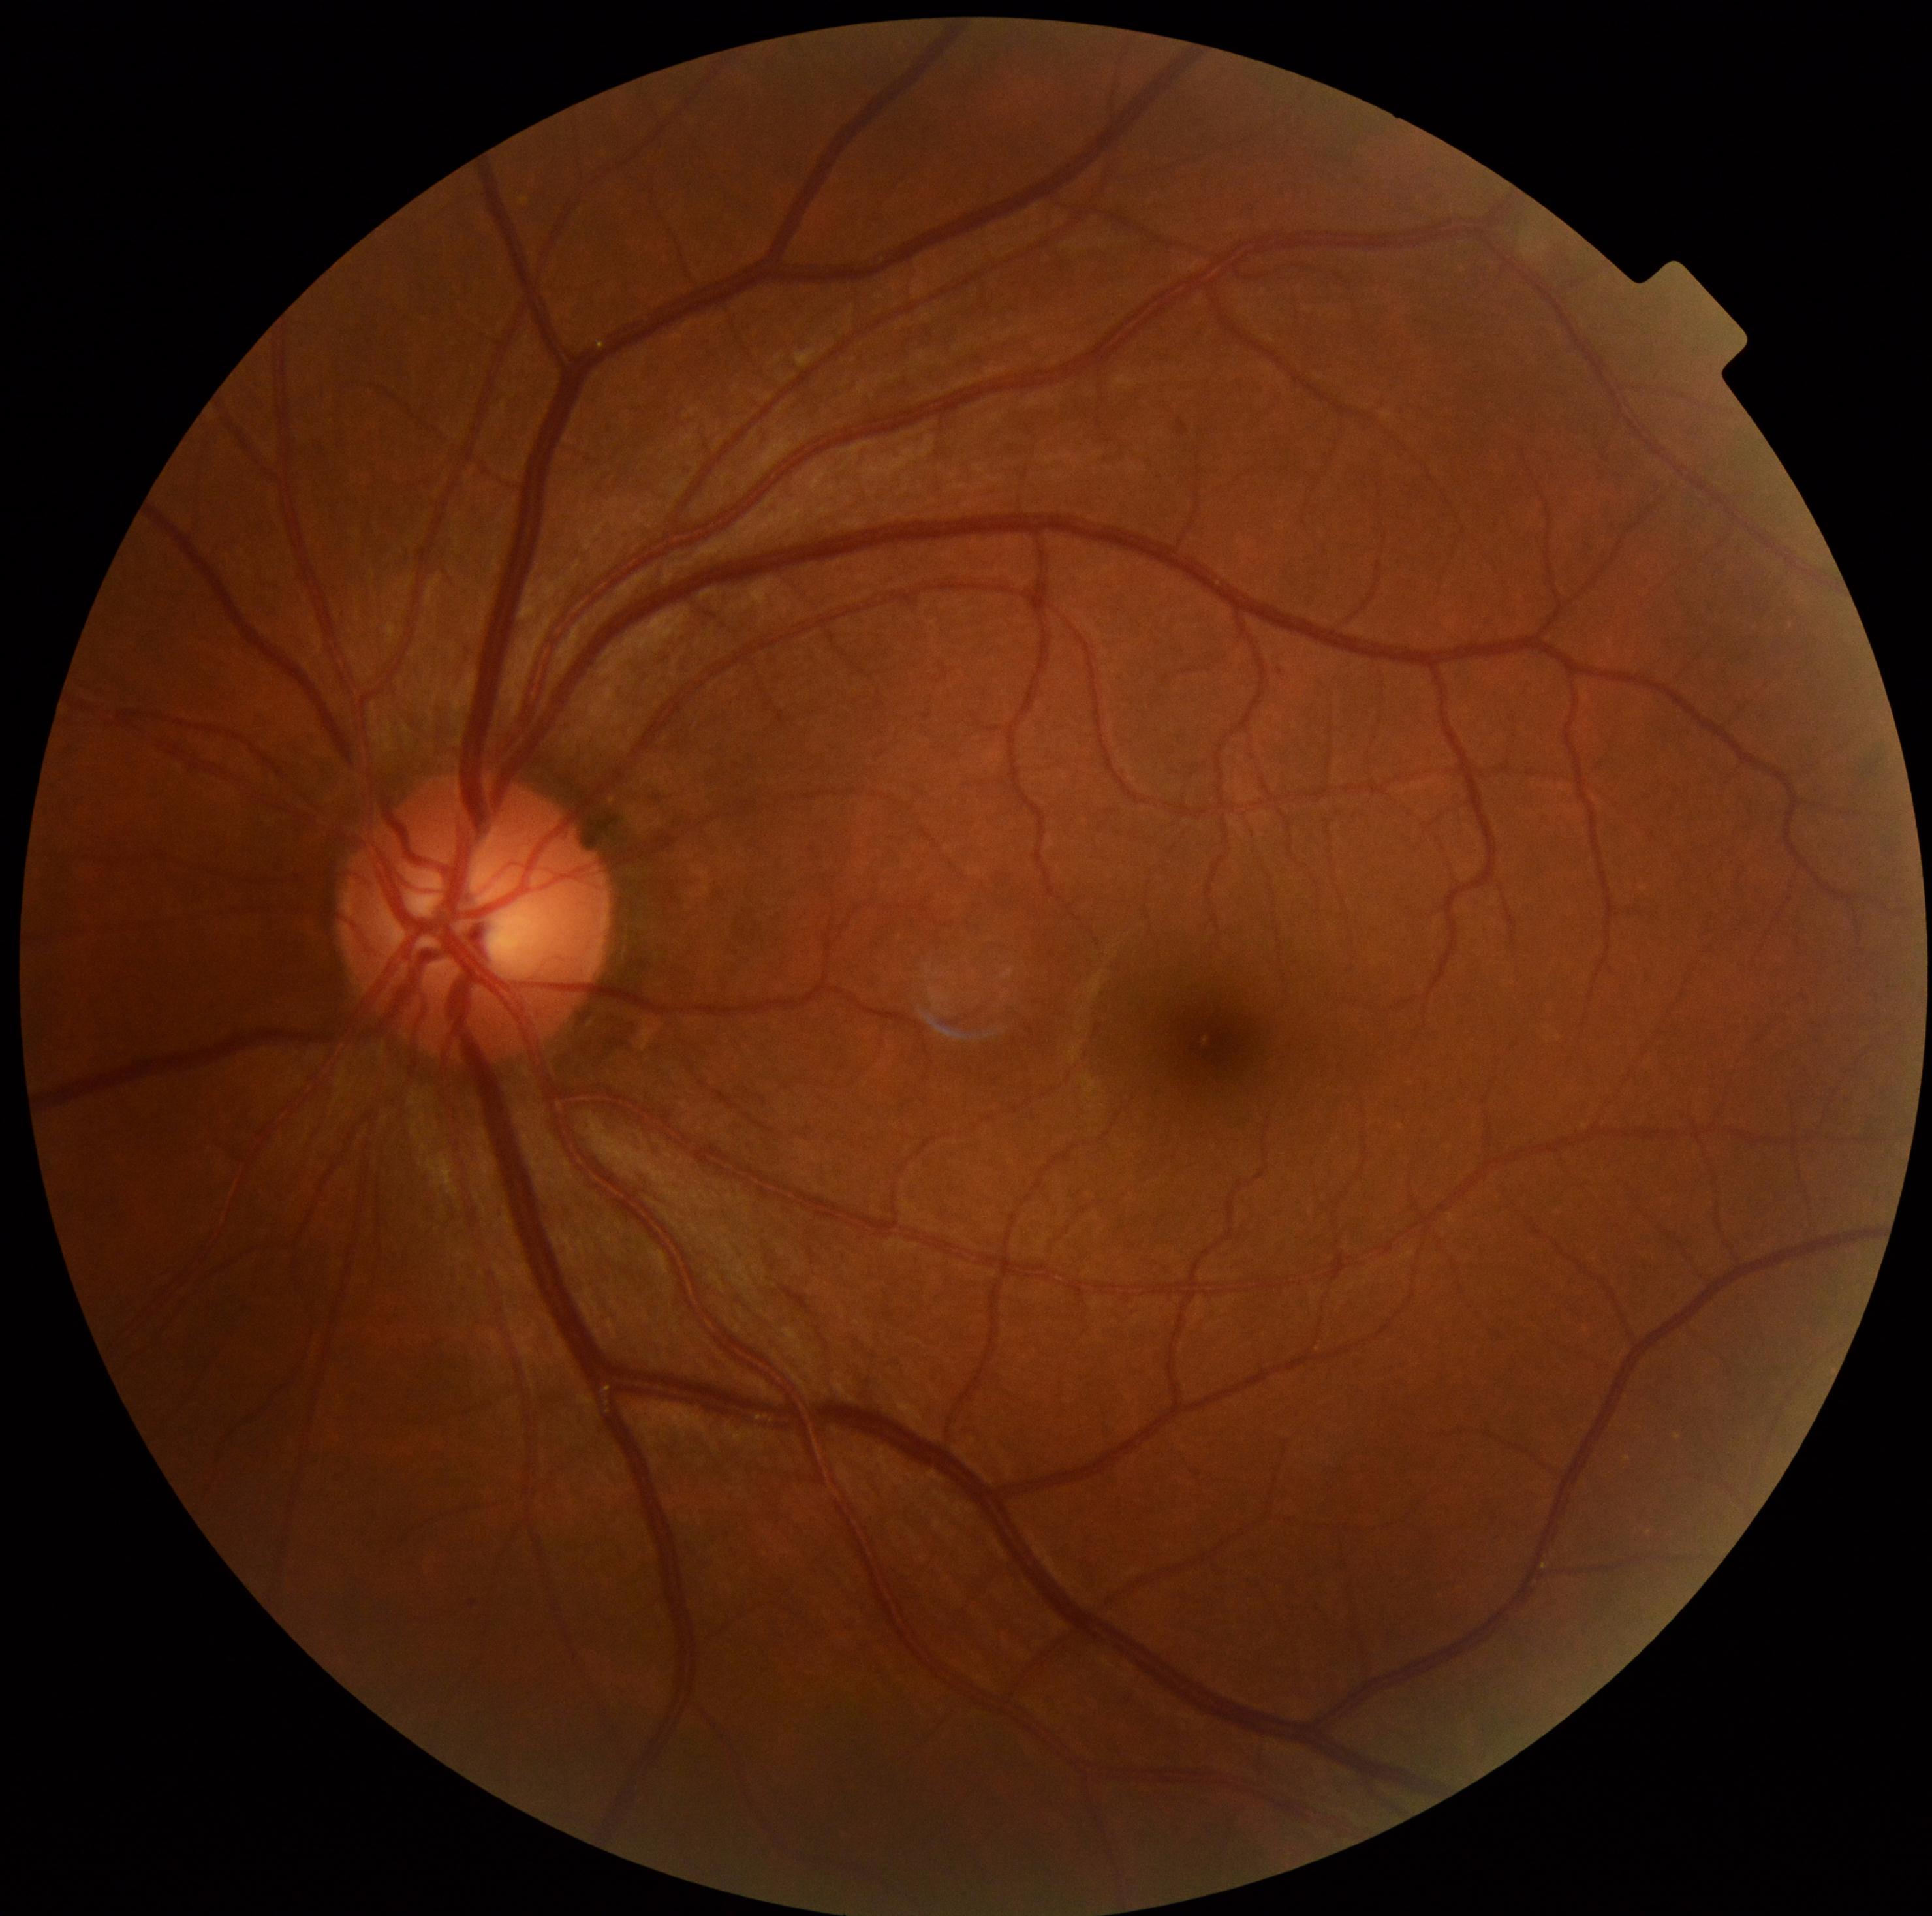
Findings:
• DR grade: 1